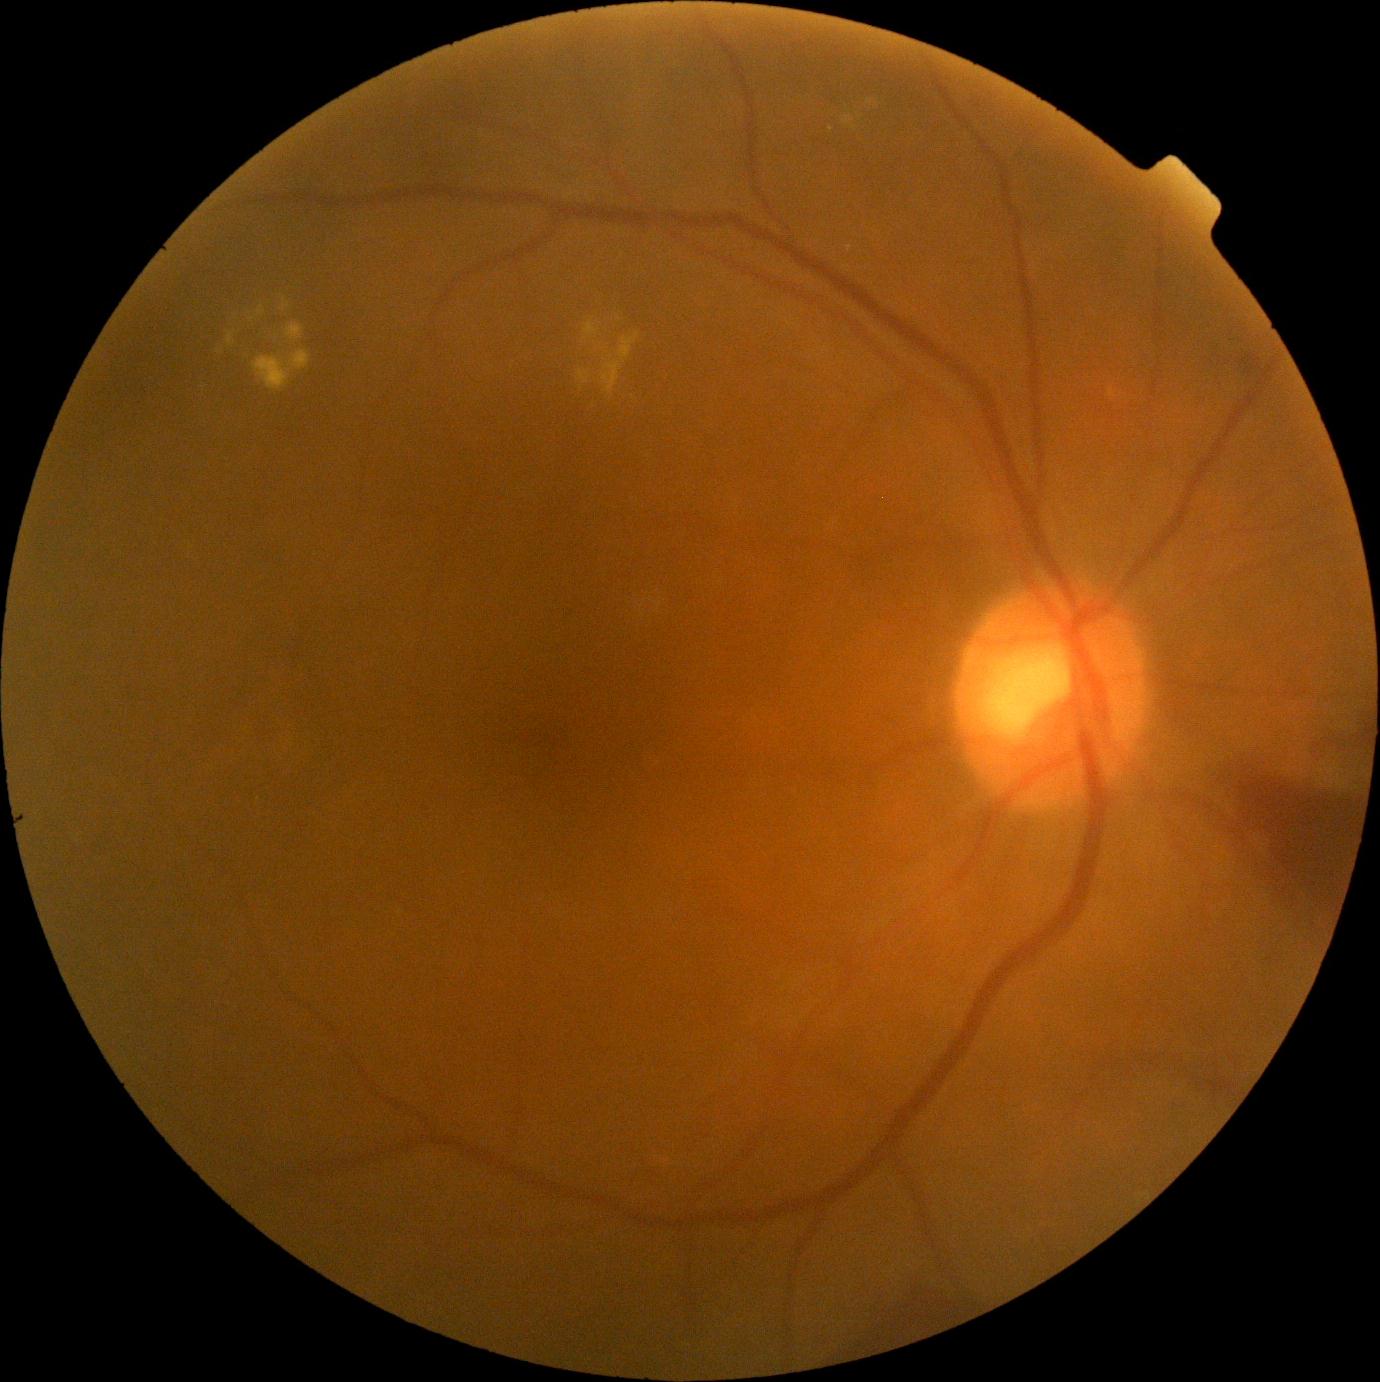

partial: true
dr_grade: 4
lesions:
  he:
    - 1232, 337, 1280, 381
    - 1167, 749, 1364, 926
    - 856, 1275, 987, 1352
  ma: []
  ex:
    - 577, 370, 591, 385
    - 1109, 389, 1117, 398
    - 619, 333, 639, 363
    - 285, 323, 304, 341
    - 602, 360, 623, 395
    - 843, 115, 857, 132
    - 584, 321, 600, 339
    - 253, 351, 311, 391
    - 227, 333, 234, 347
    - 258, 306, 266, 316
  ex_small:
    - 612, 358
    - 860, 116
    - 831, 129
    - 219, 352
    - 870, 102
    - 287, 306
    - 581, 388
    - 620, 319
  se: []